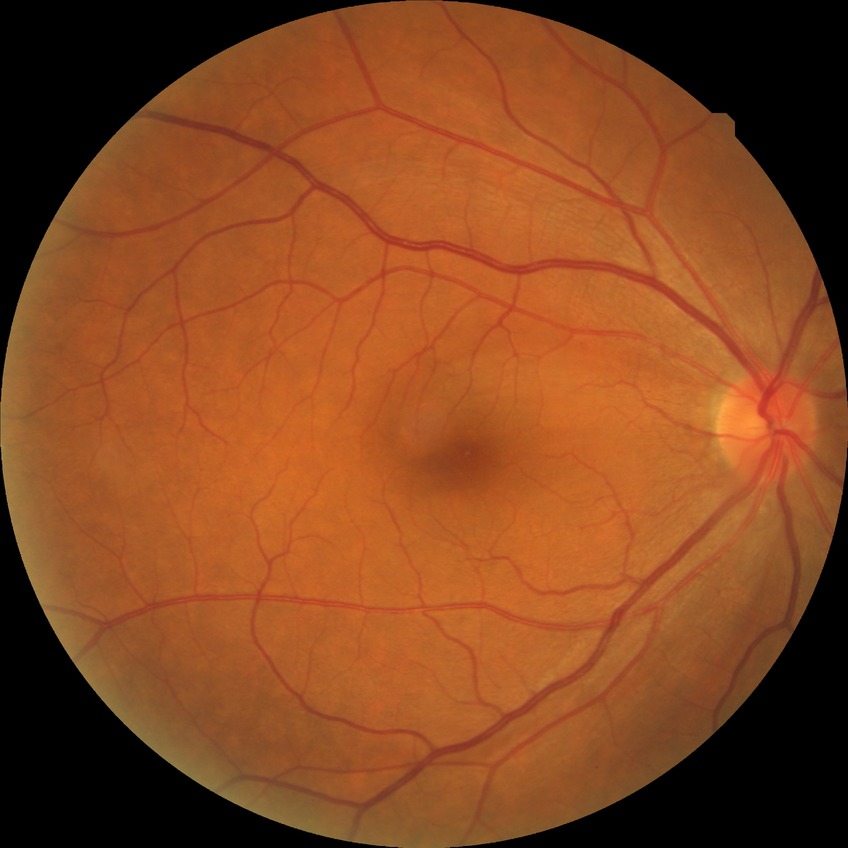 davis_grade: NDR